45° field of view, nonmydriatic, CFP
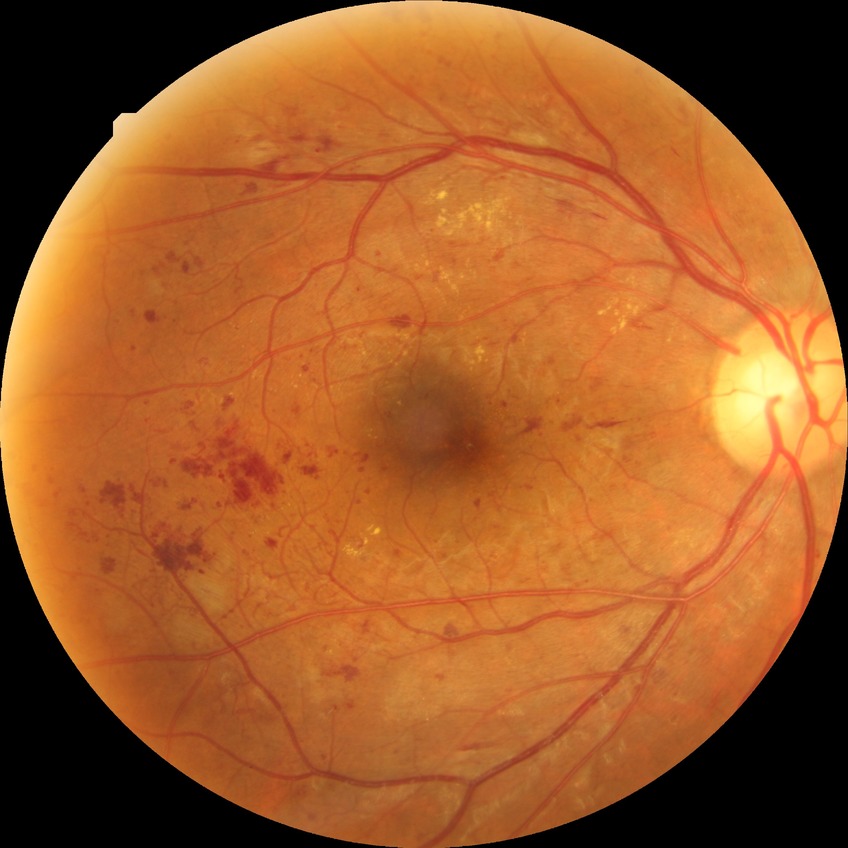 Findings:
• Davis DR grade — PDR